Color fundus photograph — 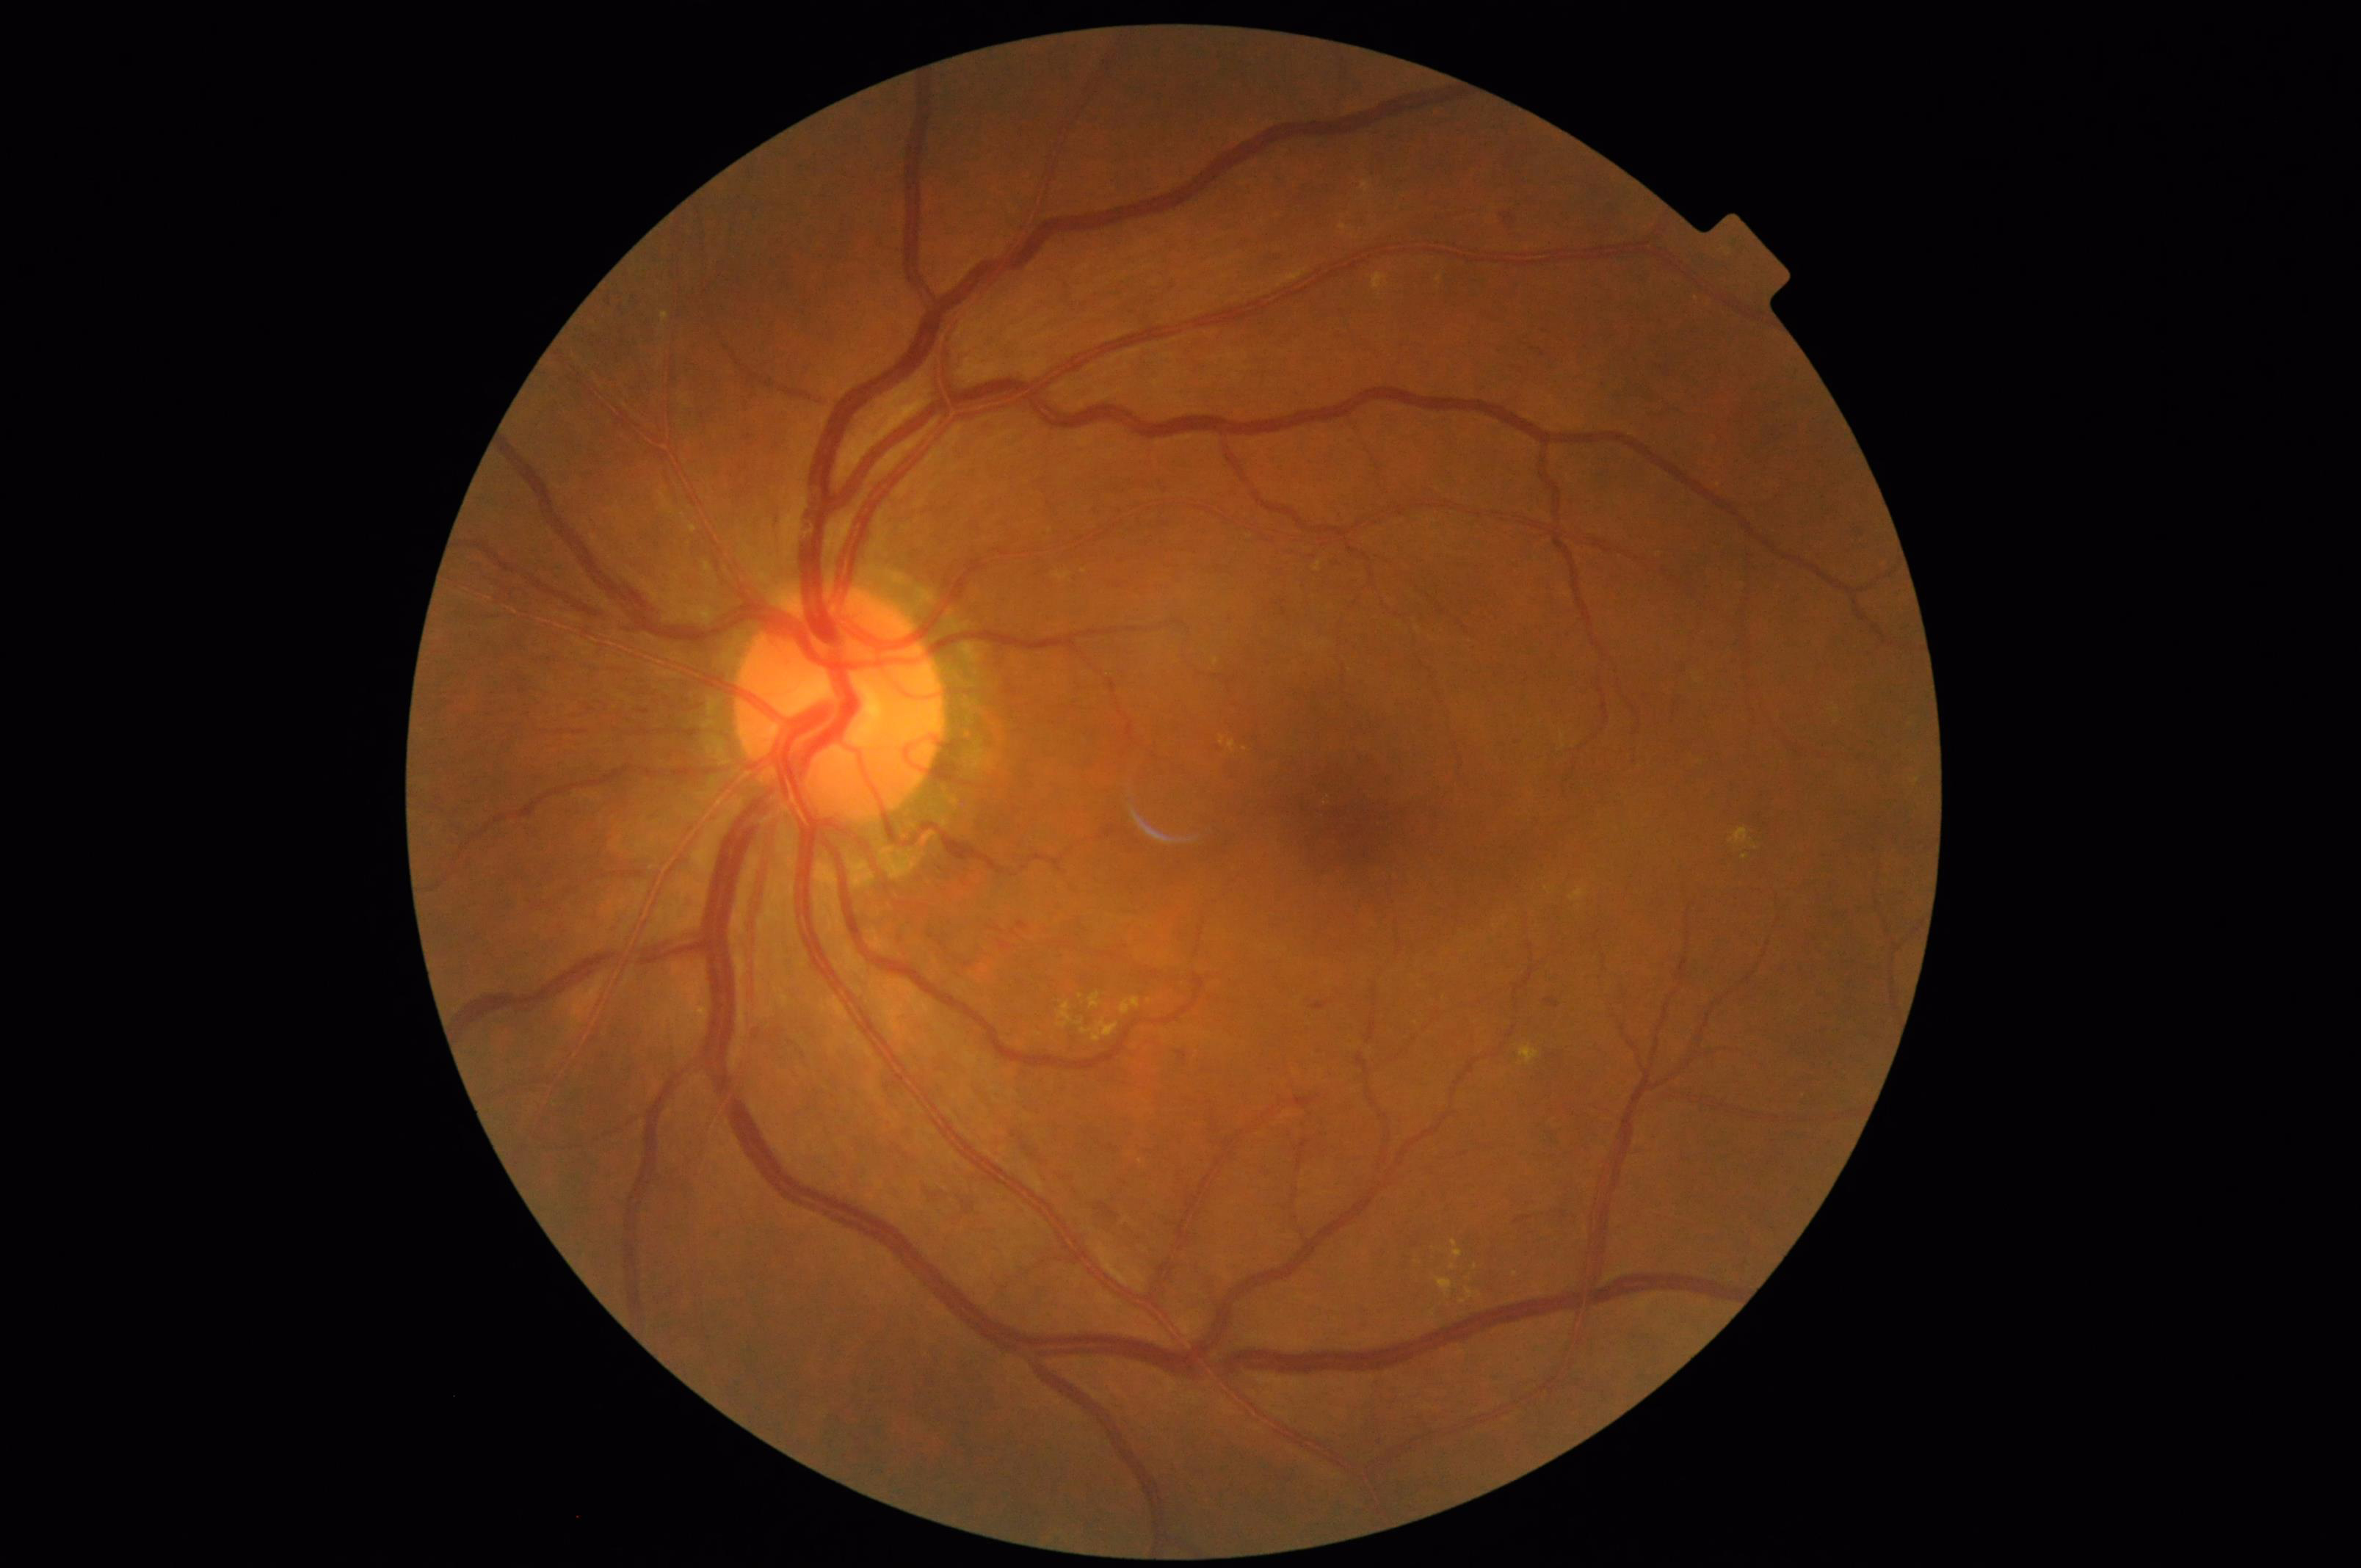
Image is sharp throughout the field. Image quality is adequate for diagnostic use. No over- or under-exposure. Adequate contrast for distinguishing structures.